Color fundus photograph
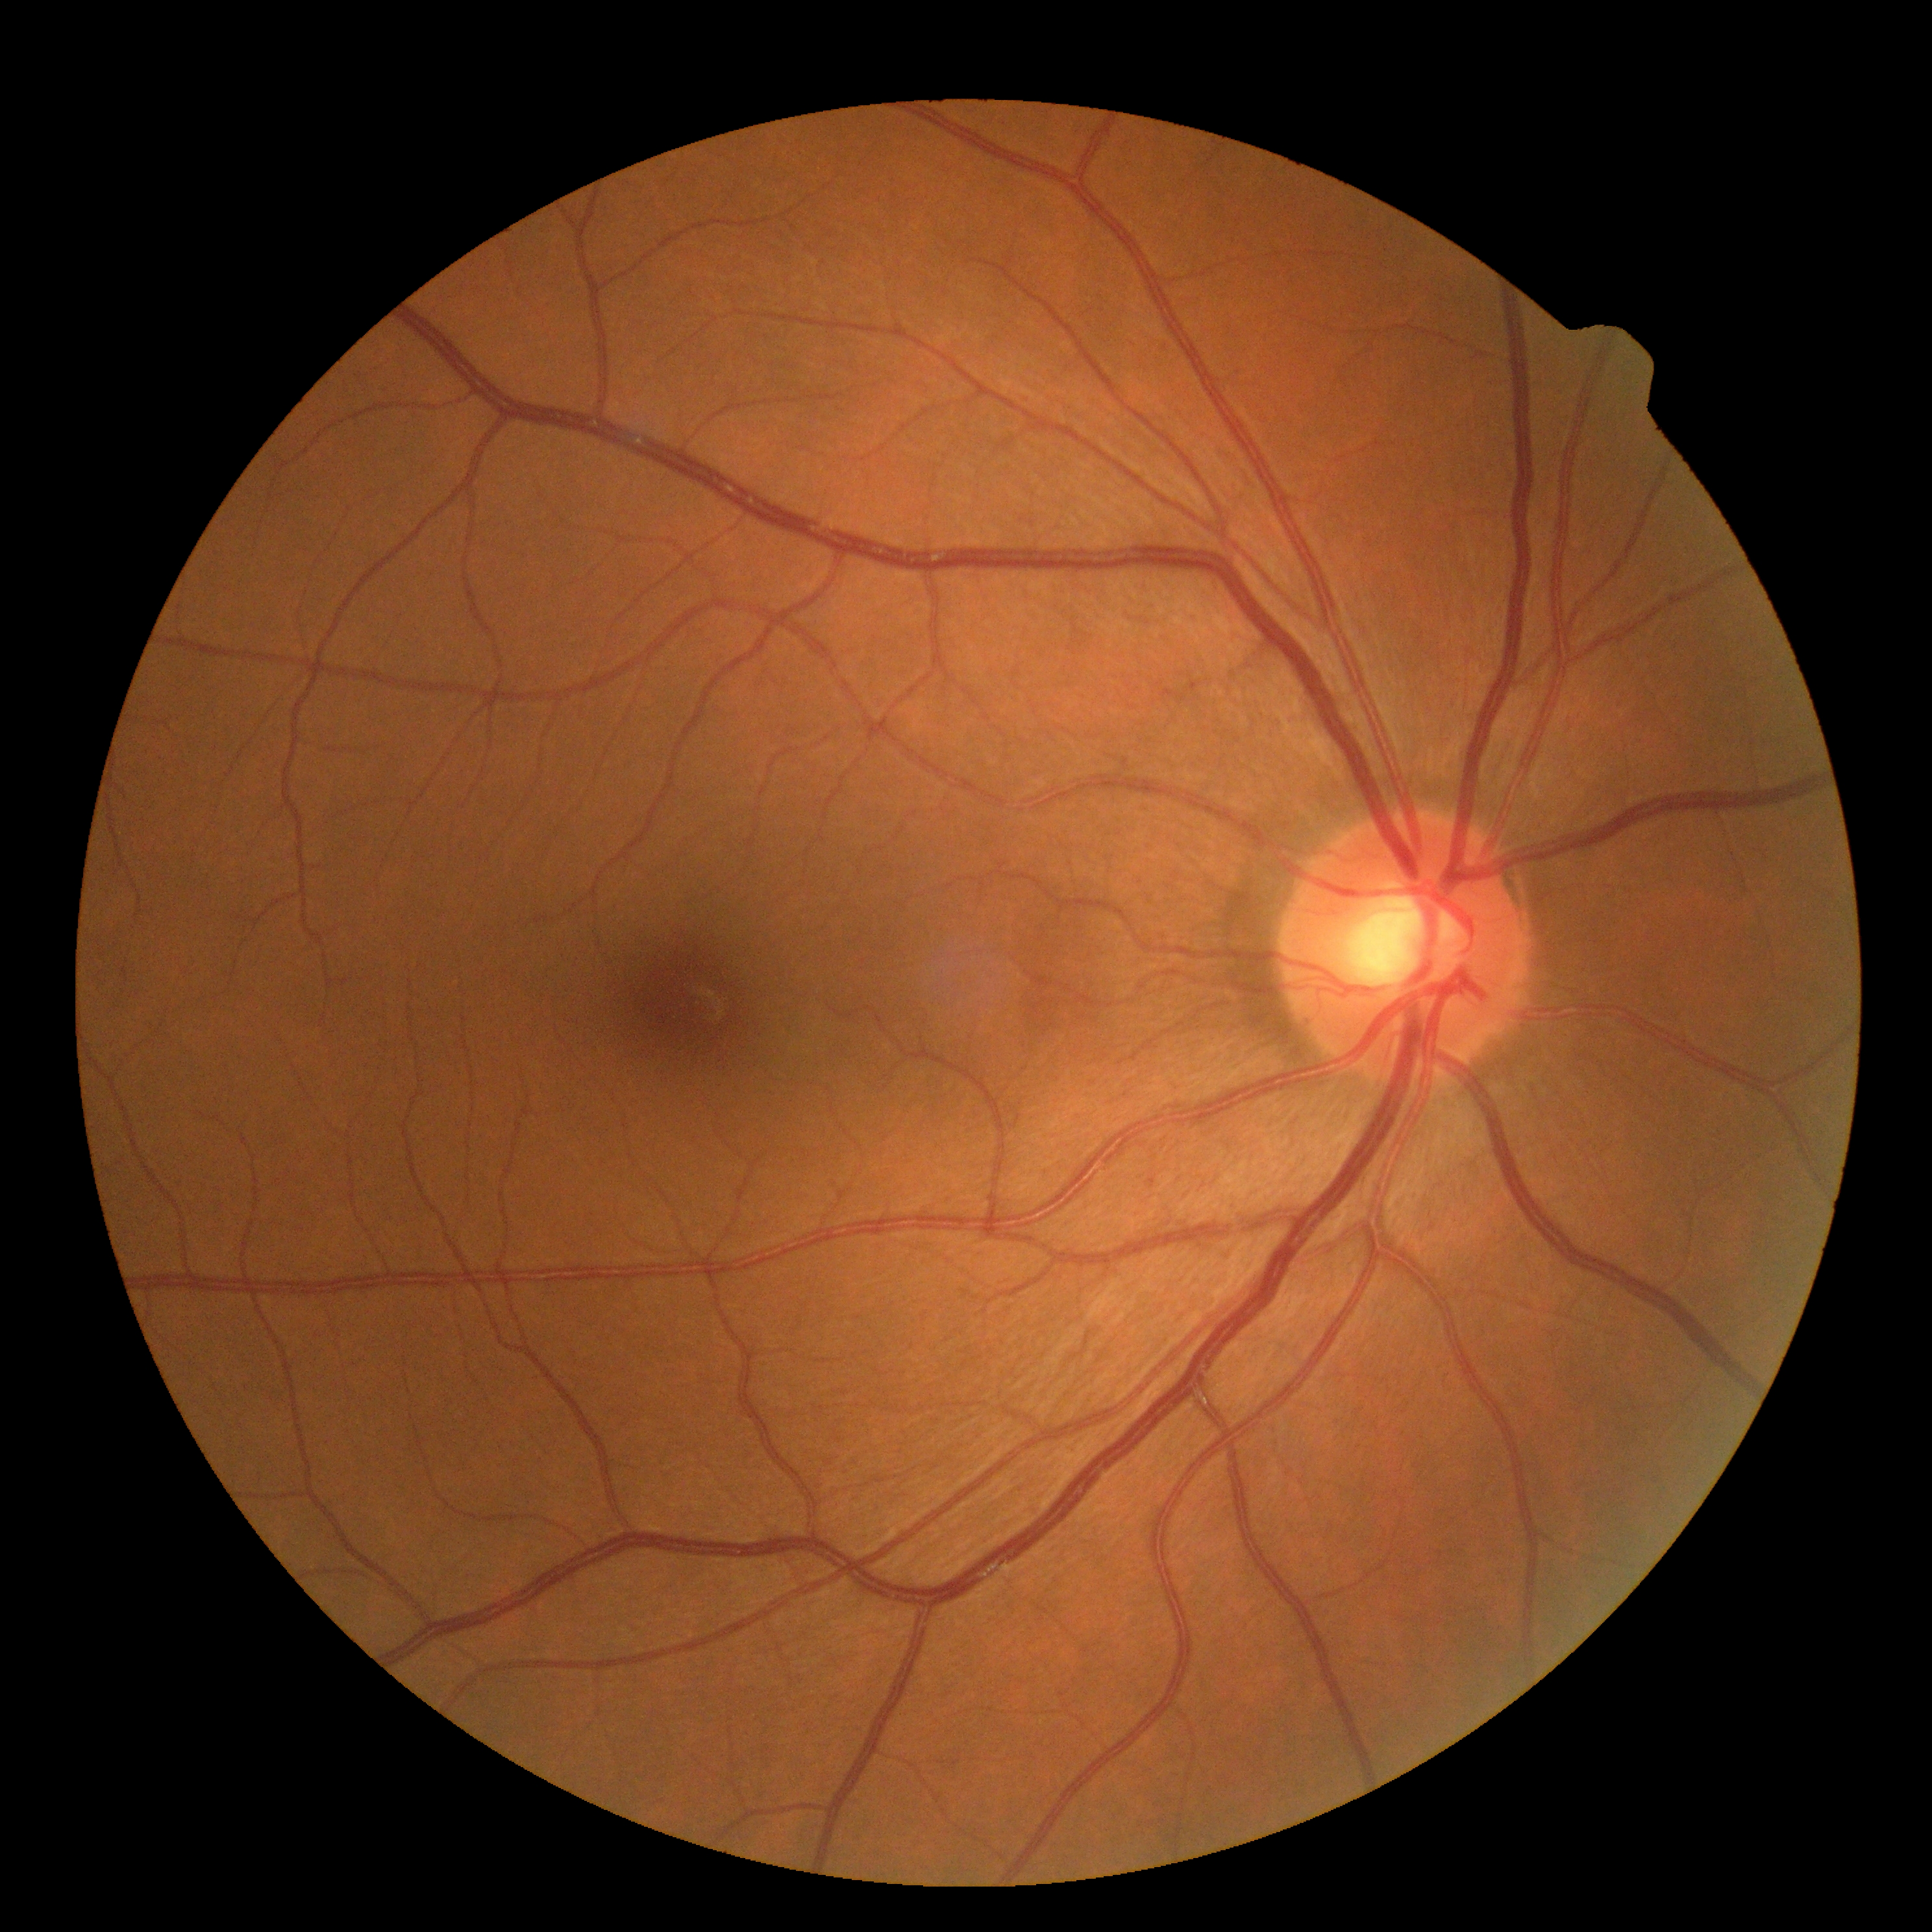

Findings:
- diabetic retinopathy — grade 0 — no visible signs of diabetic retinopathy
- DR impression — no signs of DR